45 degree fundus photograph. Davis DR grading
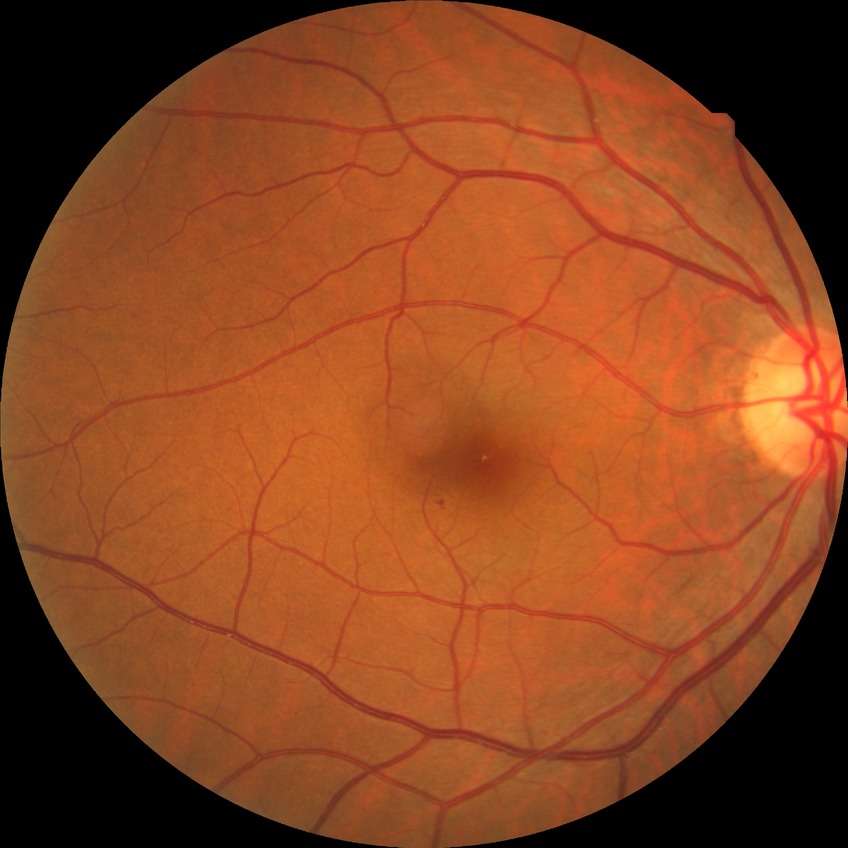 Davis grade = SDR.